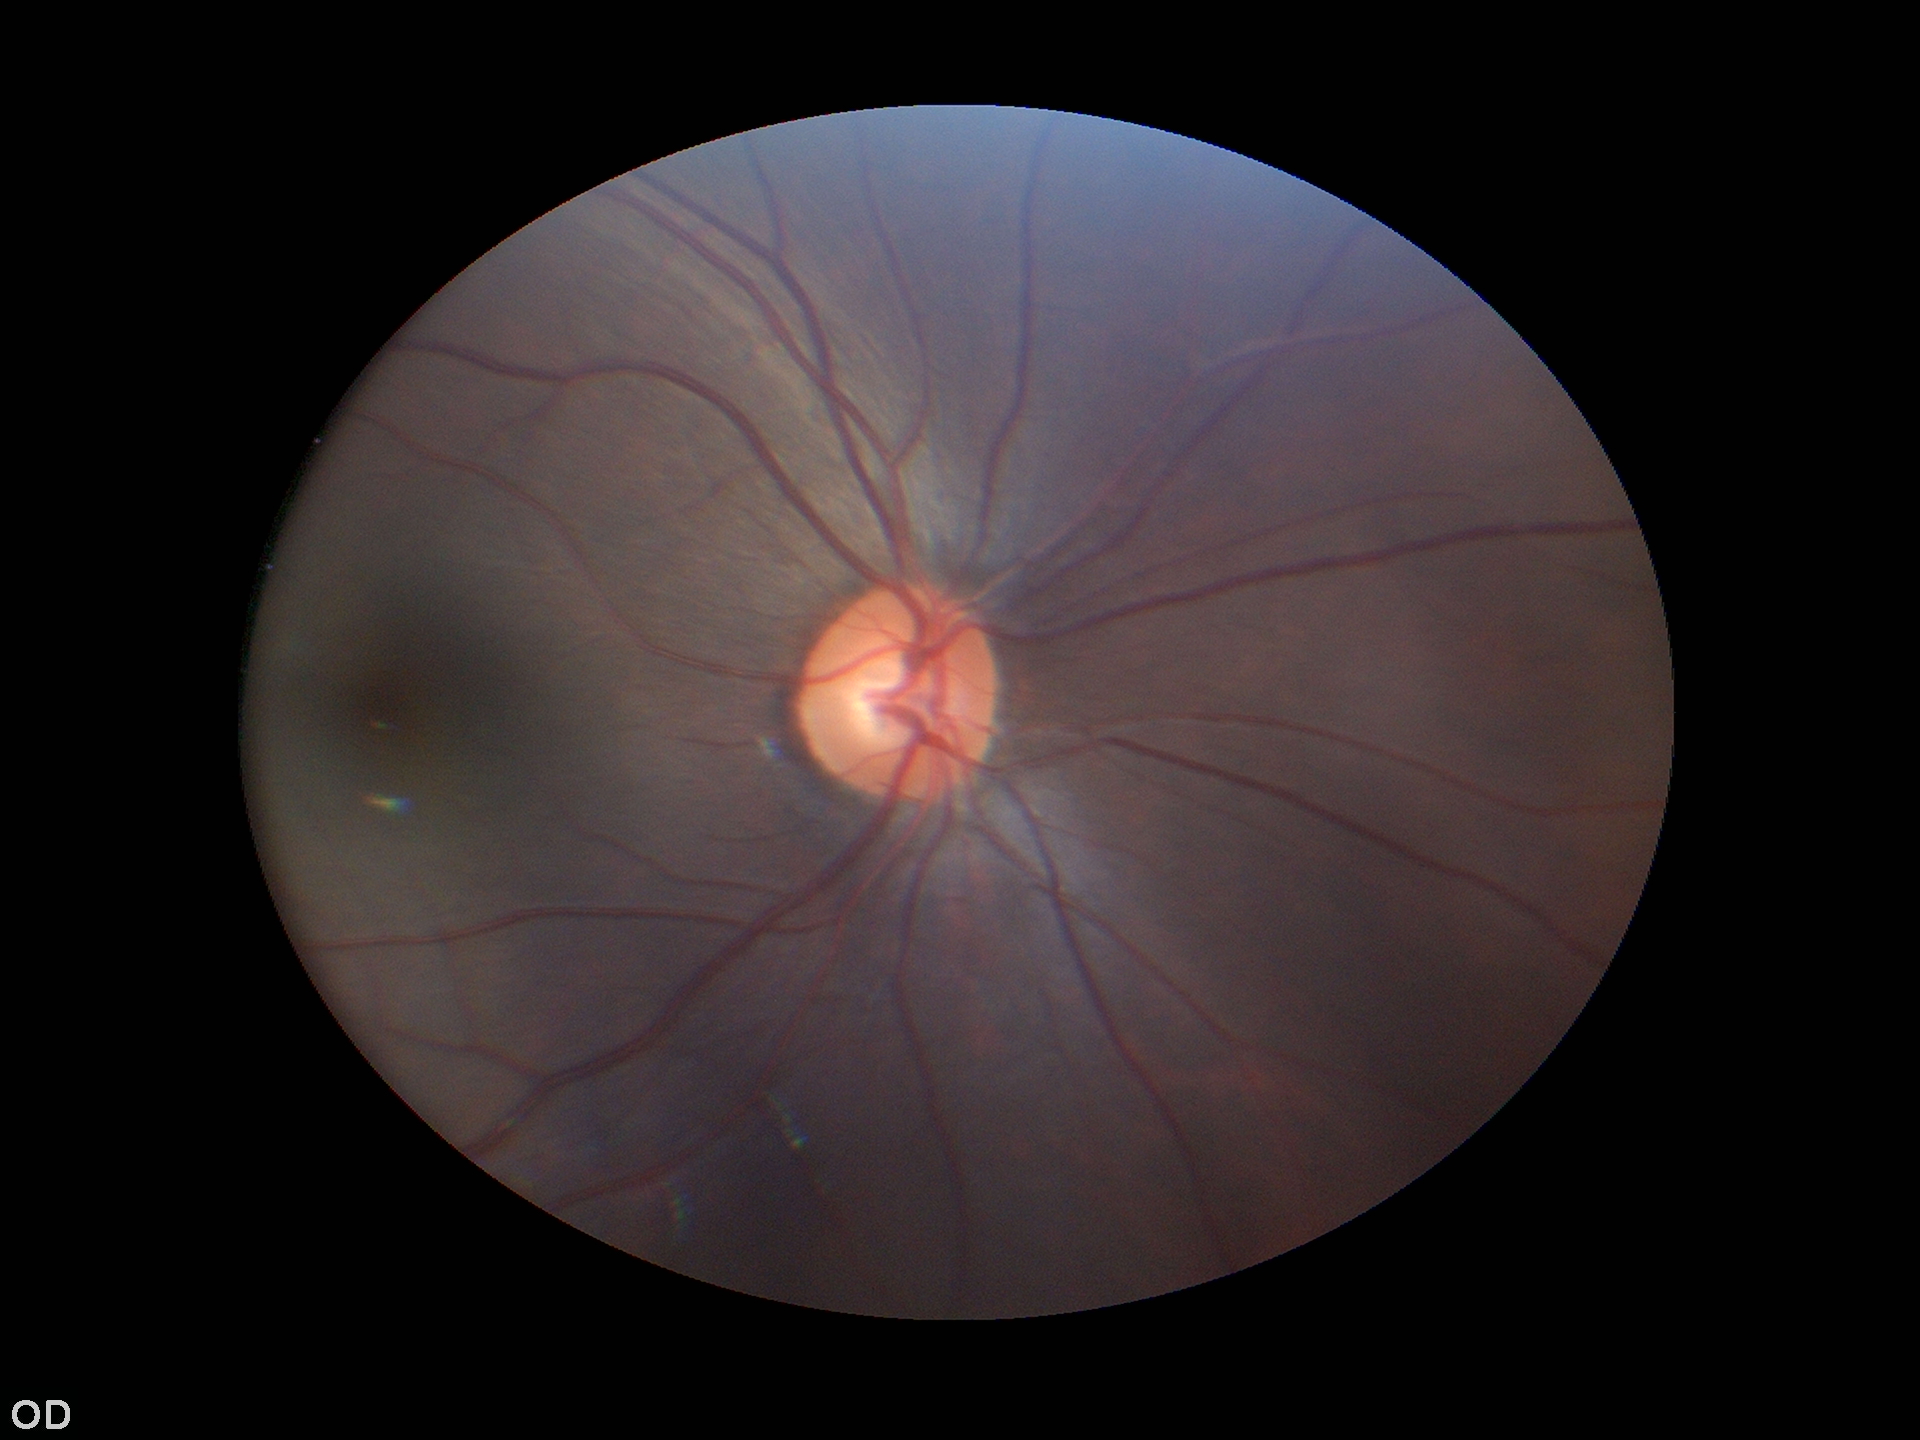
Q: Is there glaucoma suspicion?
A: not suspect
Q: What is the vertical cup-to-disc ratio?
A: 0.51
Q: What is the area cup-to-disc ratio?
A: 0.29